45-degree field of view; DR severity per modified Davis staging; image size 848x848; nonmydriatic fundus photograph — 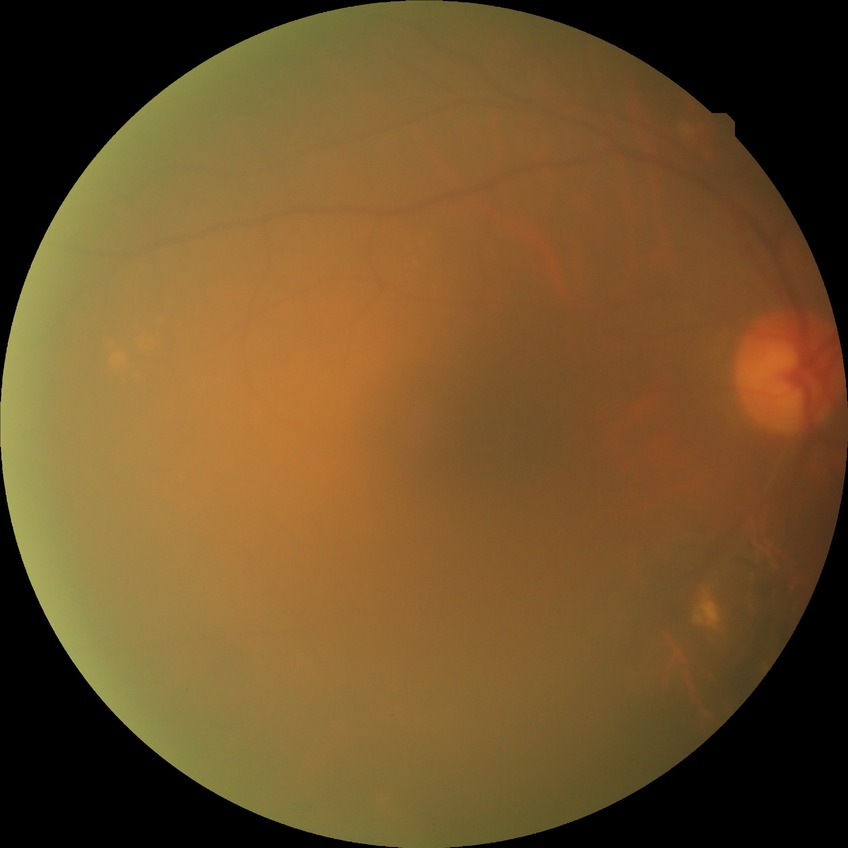
diabetic retinopathy (DR): no diabetic retinopathy (NDR).